Image size 640x480; wide-field fundus photograph from neonatal ROP screening — 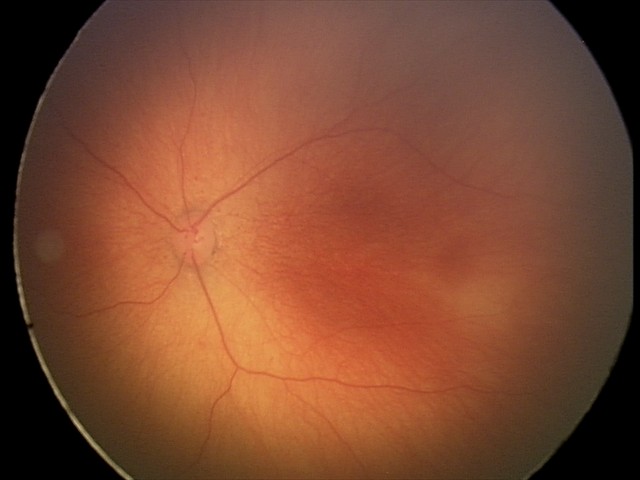 Without plus disease. Diagnosis from this screening exam: ROP stage 1.